45° field of view — 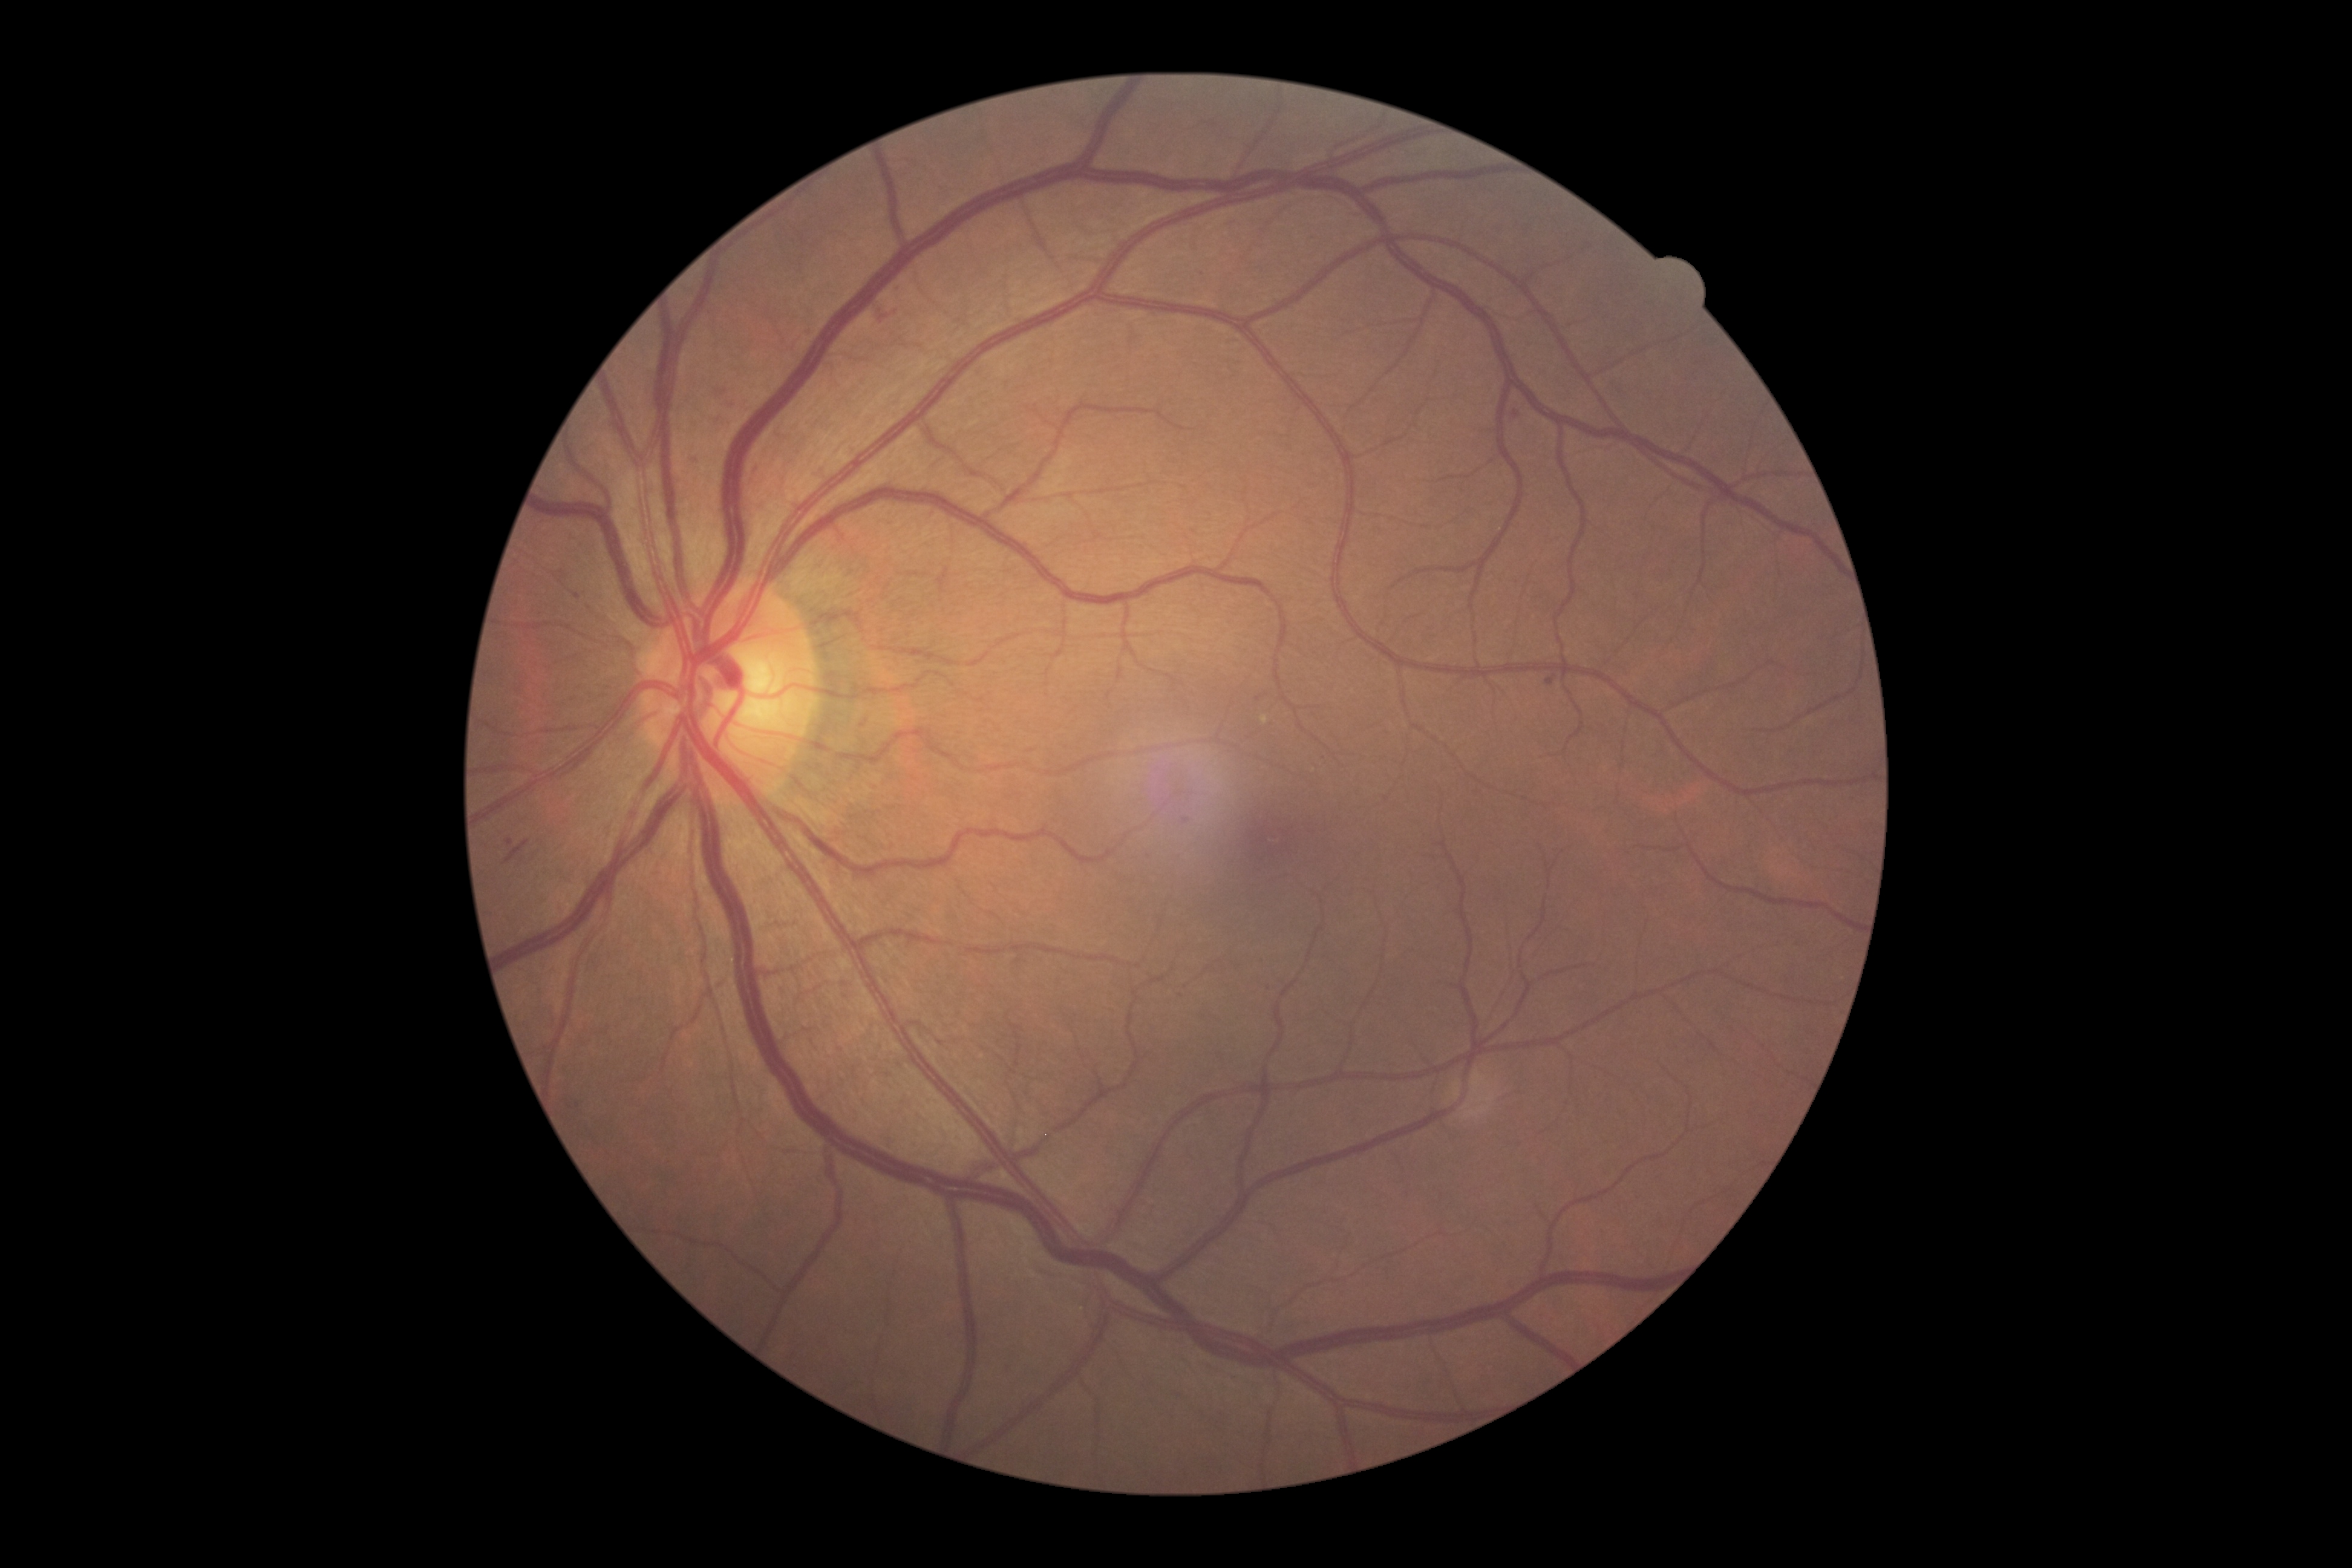 retinopathy grade: 2.